Image size 2352x1568.
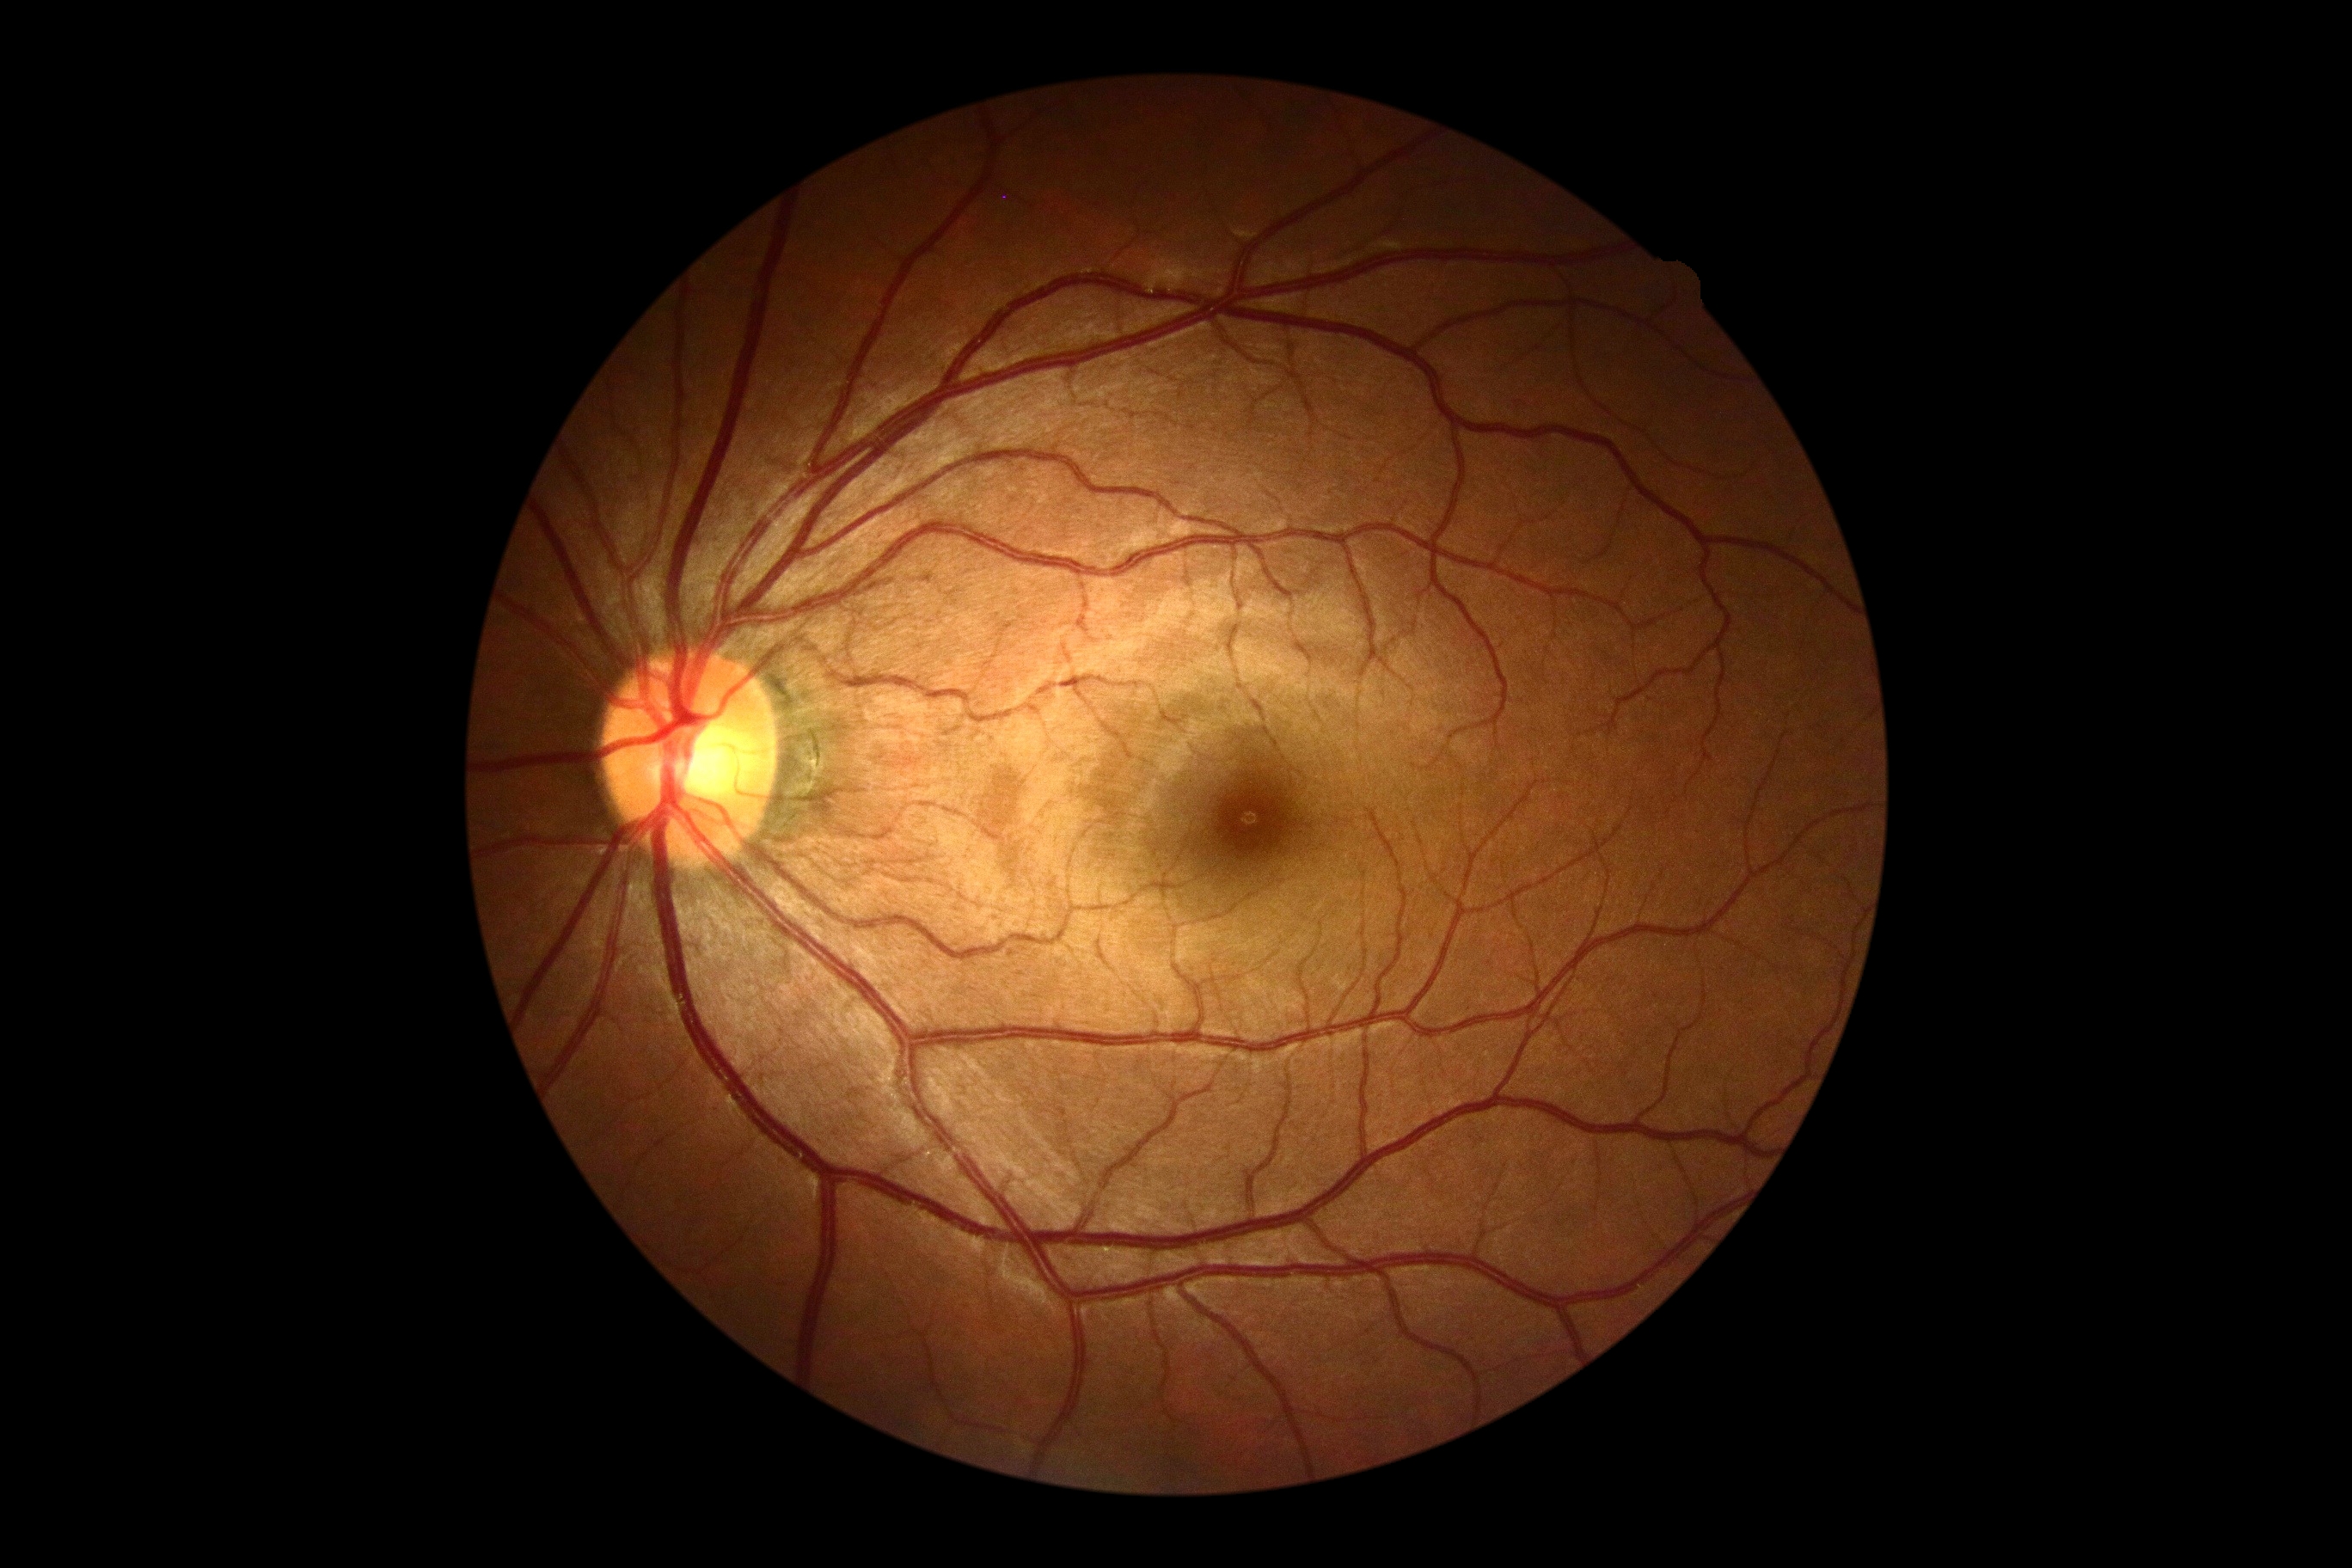

Diabetic retinopathy severity is grade 0.